848x848 · CFP · graded on the modified Davis scale:
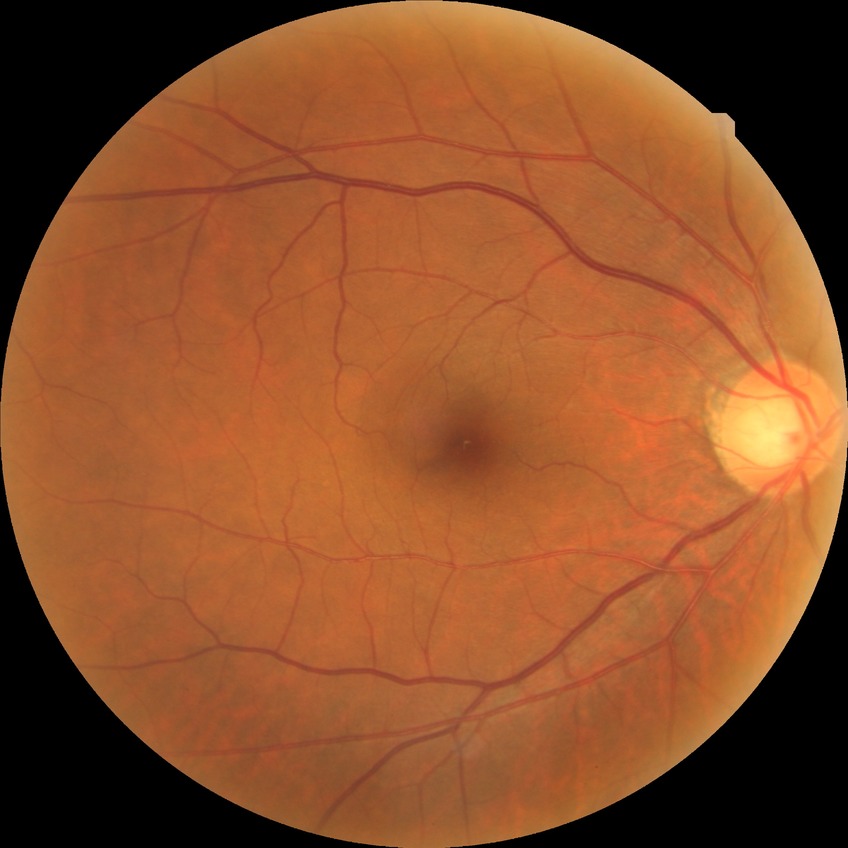
diabetic retinopathy (DR)@NDR (no diabetic retinopathy).